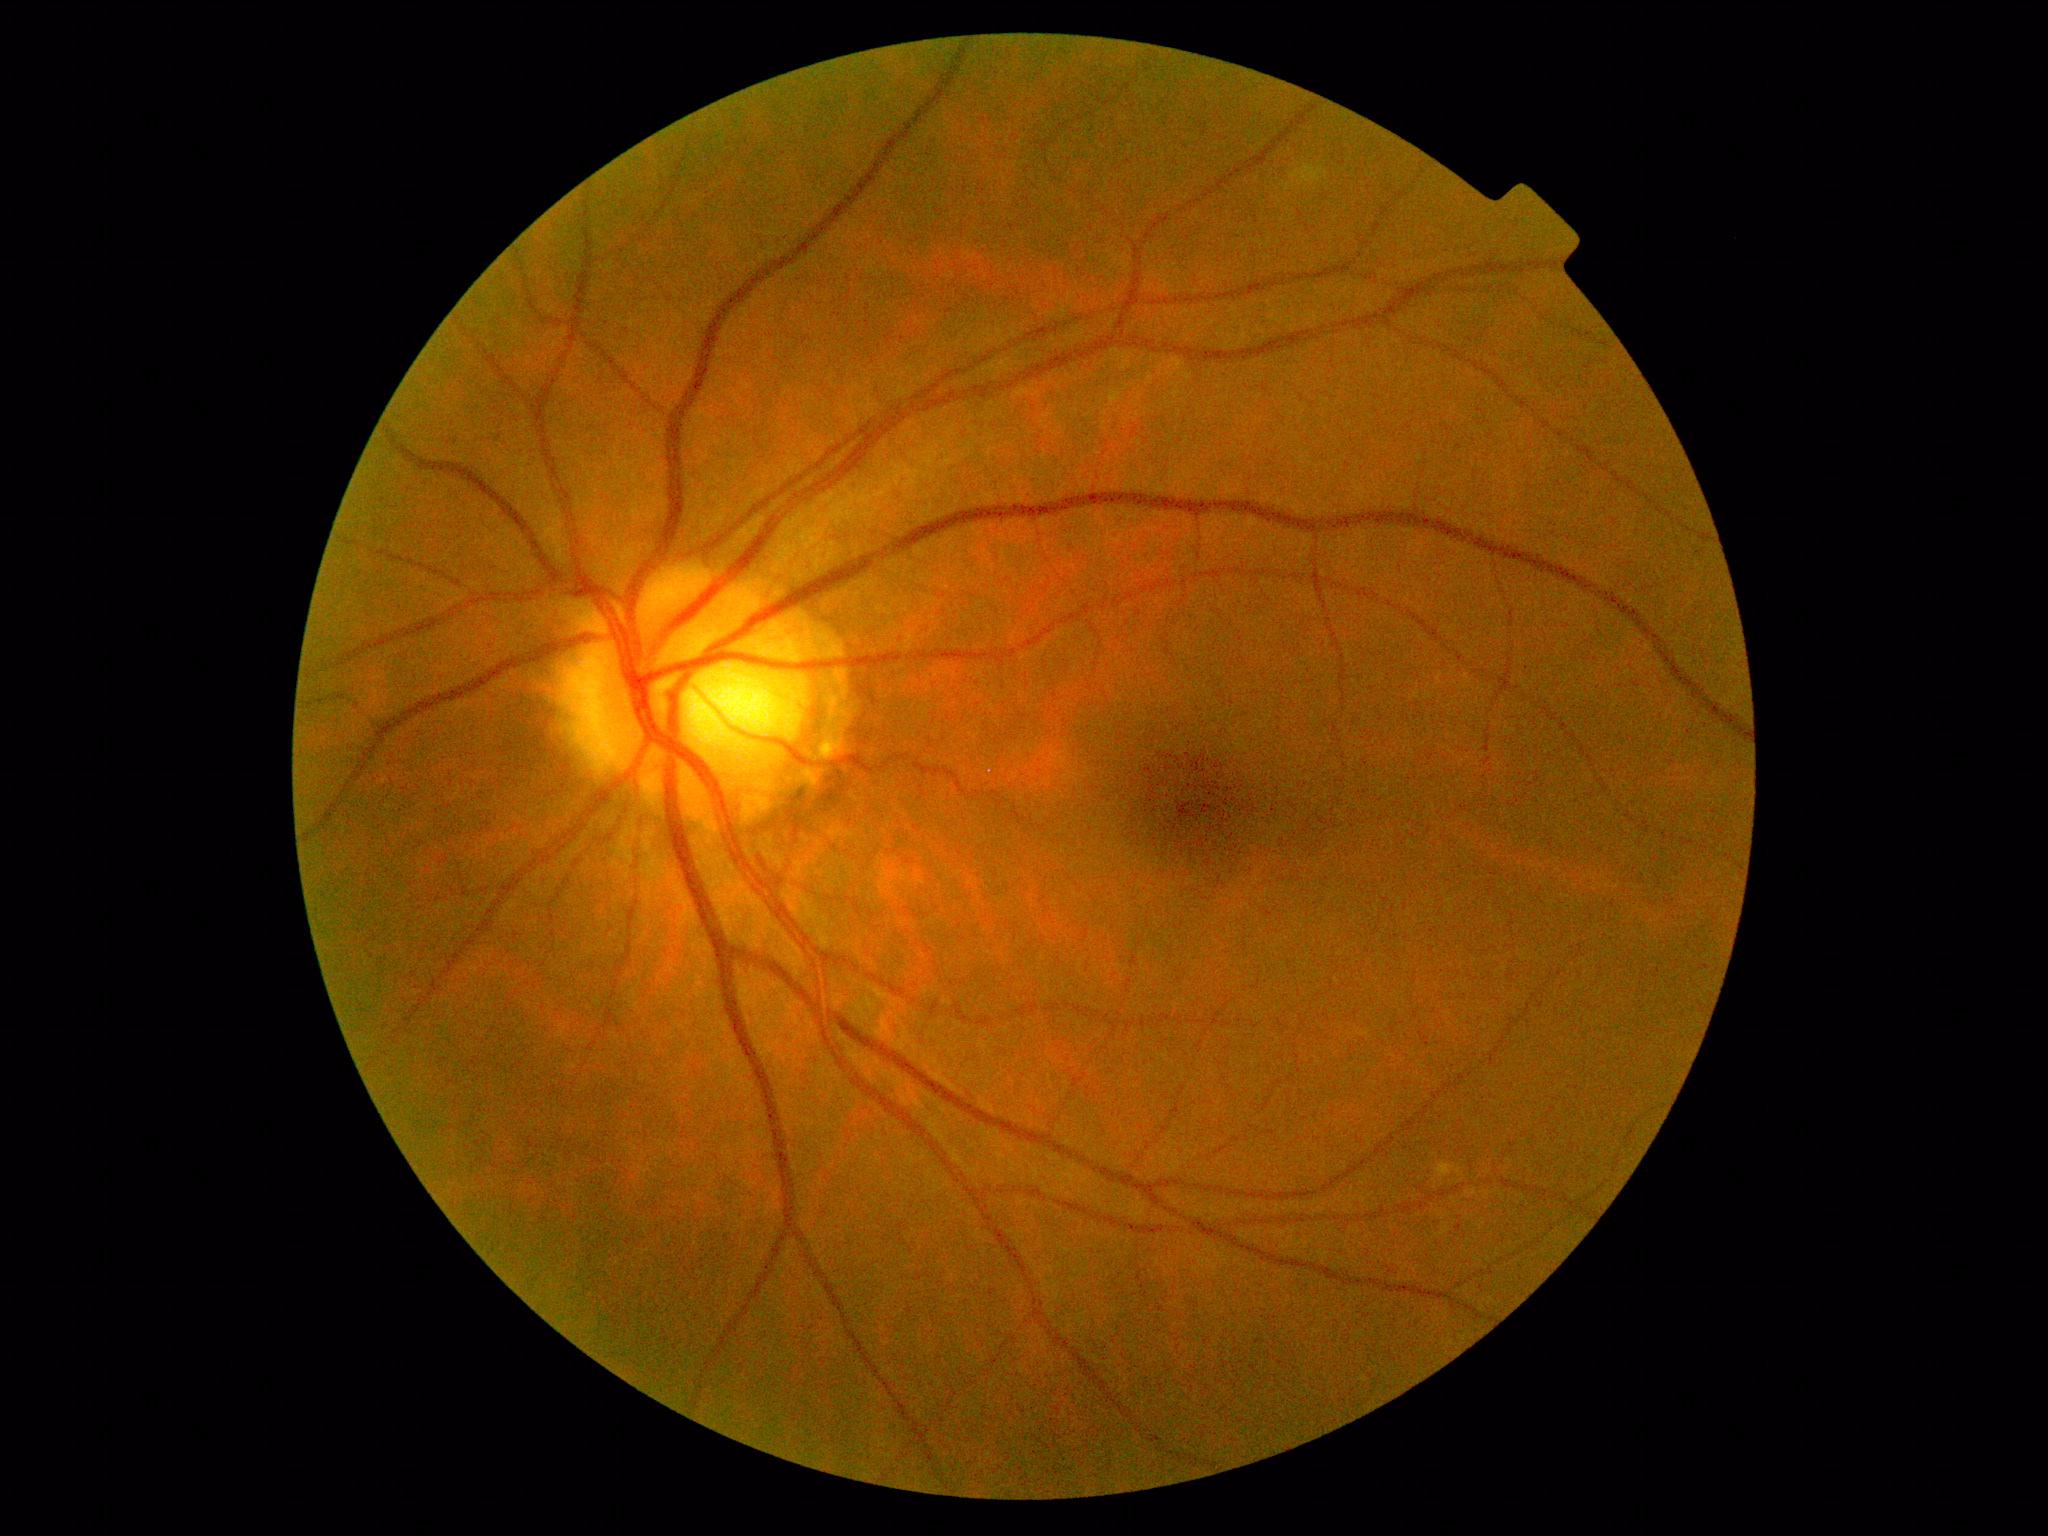
No DR findings. Retinopathy grade is 0/4.